Color fundus photograph. FOV: 45 degrees: 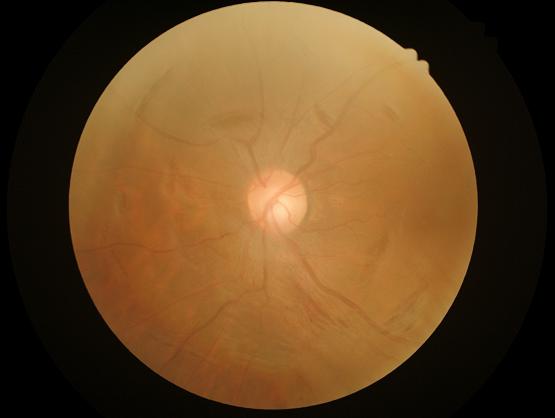

{"clarity": "out of focus", "contrast": "poor", "overall_quality": "low", "illumination": "even"}